Without pupil dilation, camera: NIDEK AFC-230 — 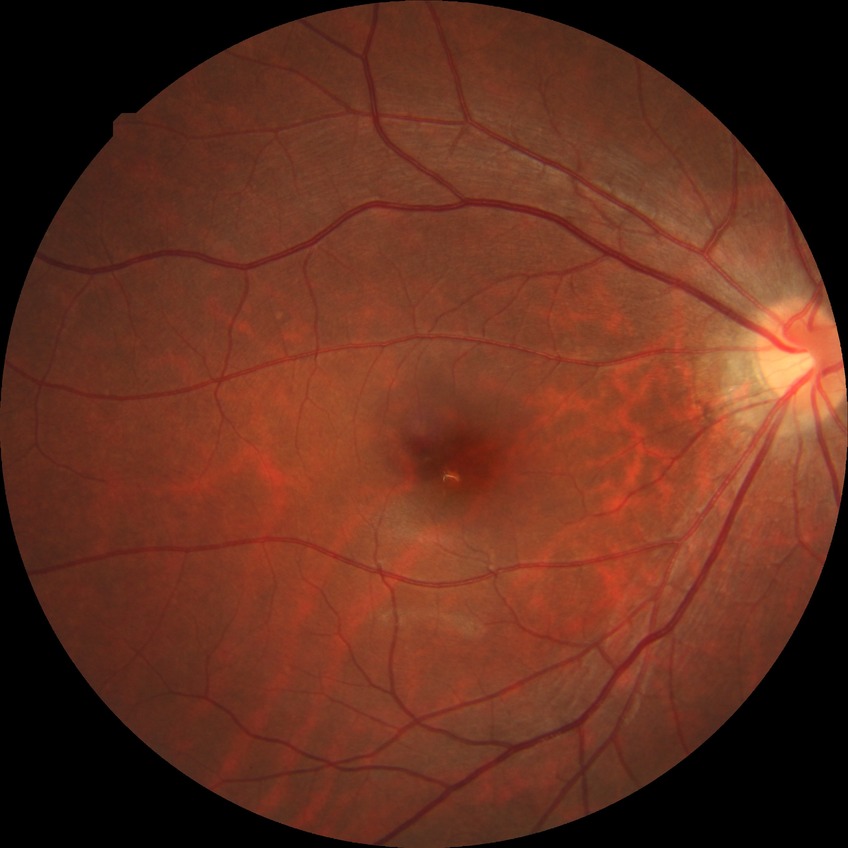

Diabetic retinopathy (DR) is NDR (no diabetic retinopathy).